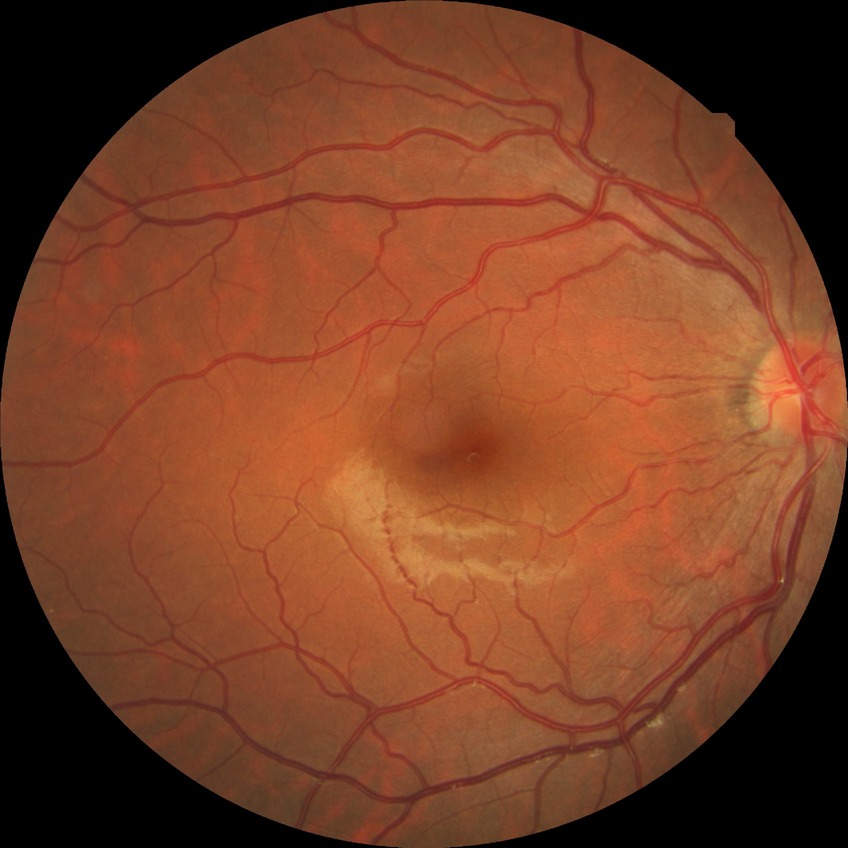

DR grade is NDR. No signs of diabetic retinopathy.